45-degree field of view; 2048 x 1536 pixels; retinal fundus photograph:
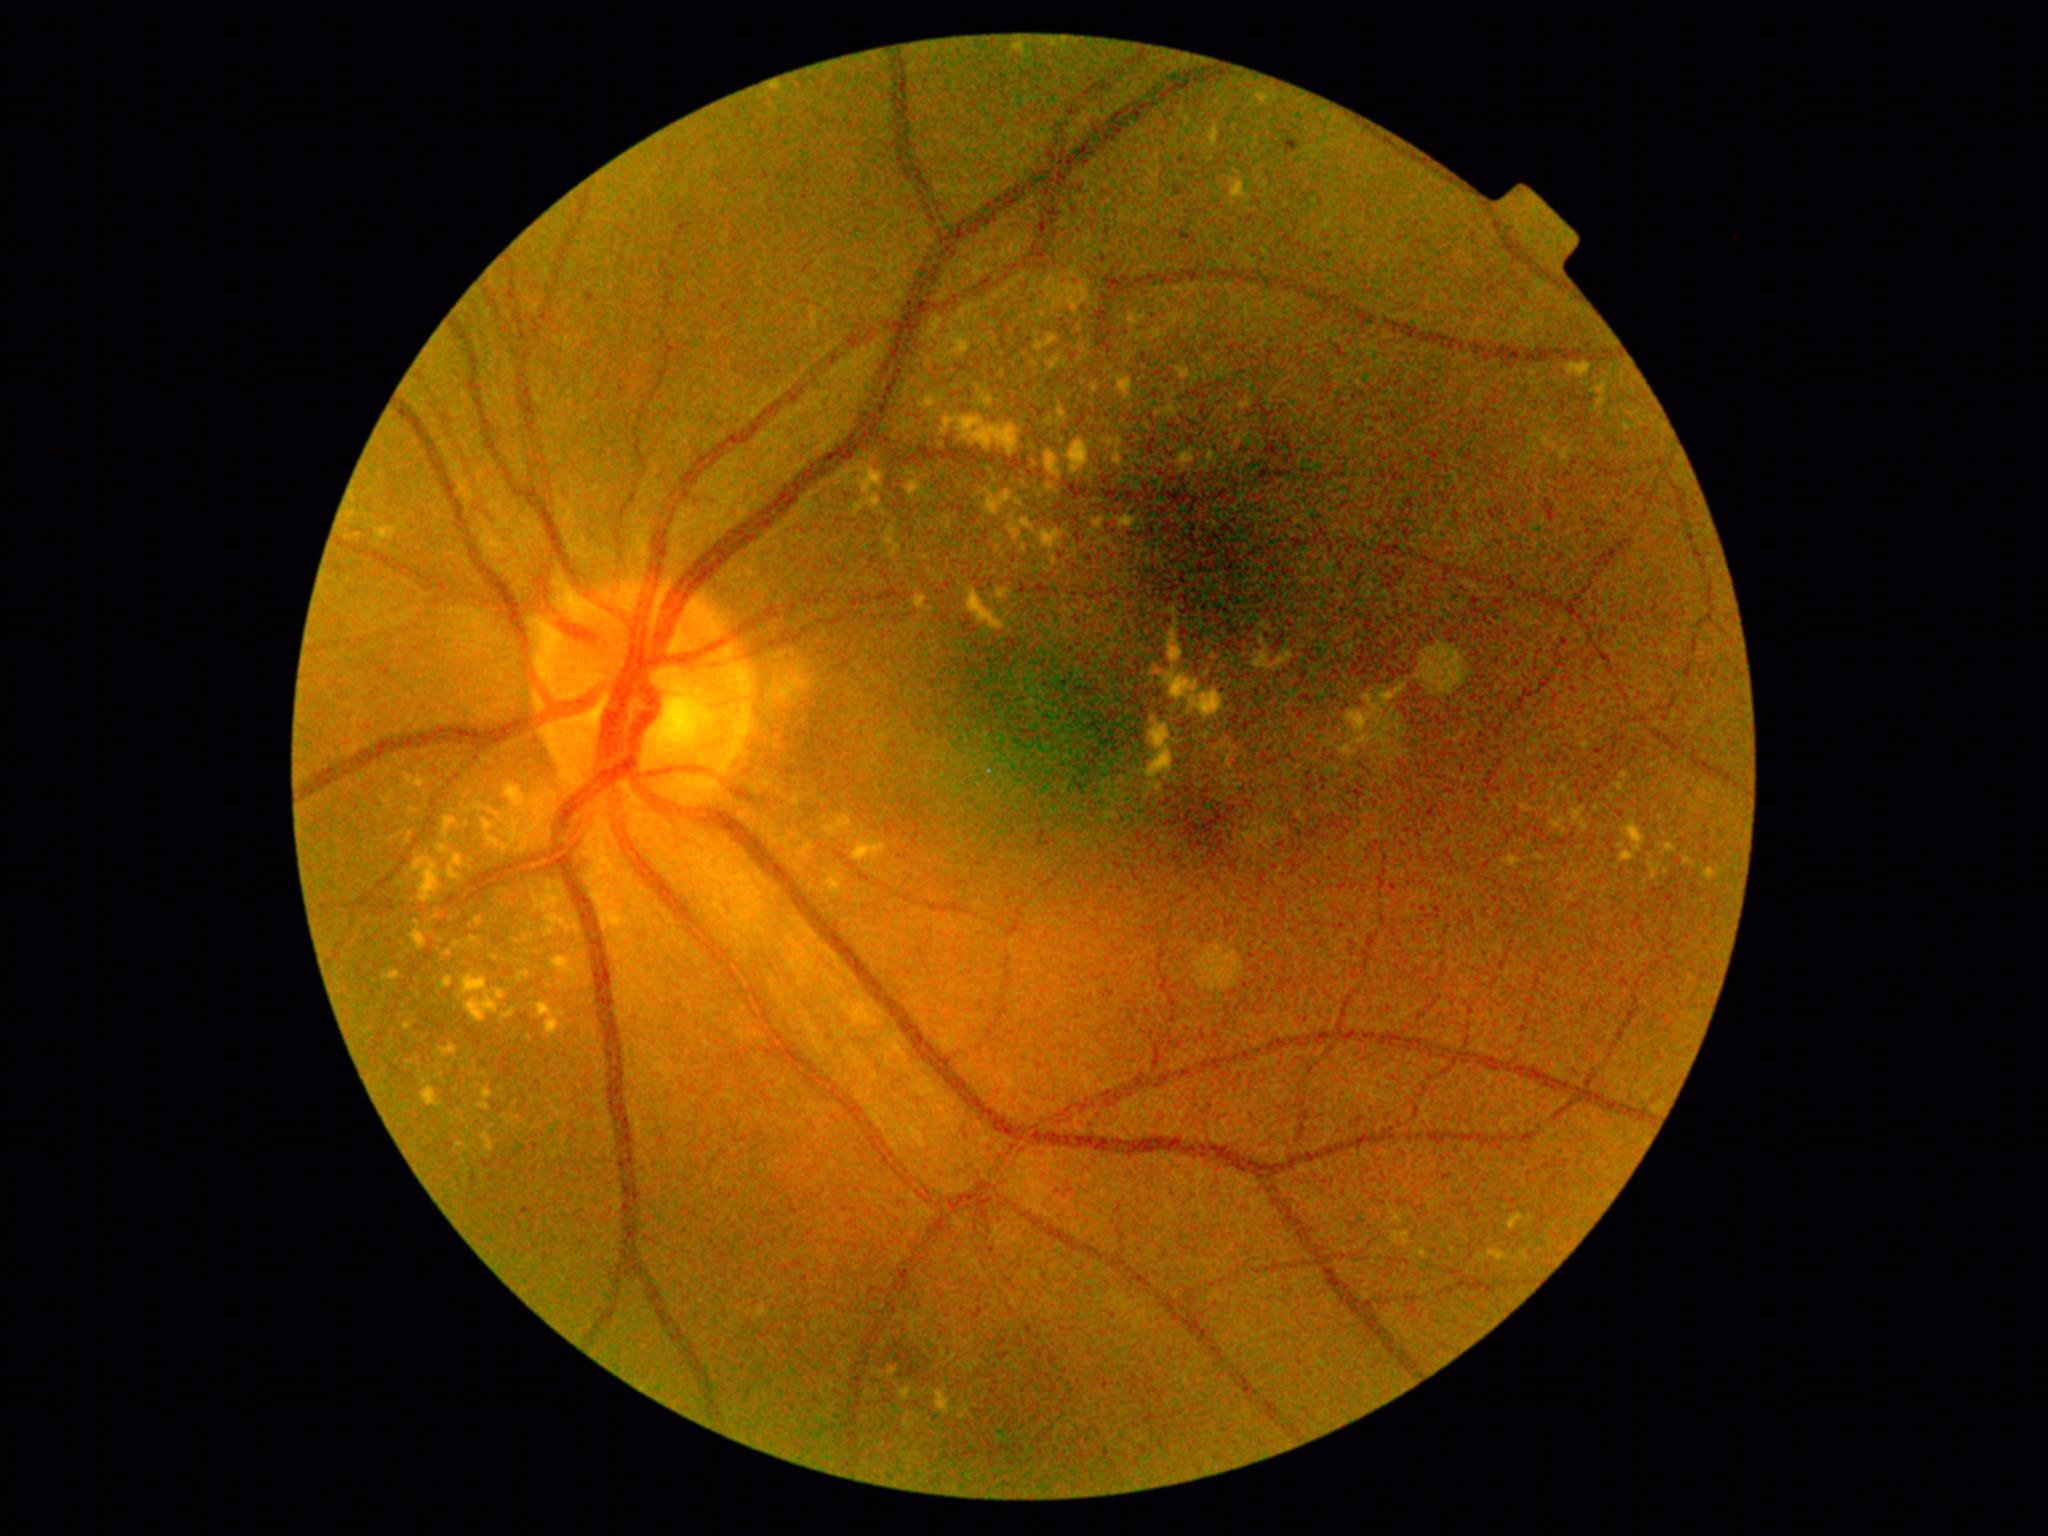 Diabetic retinopathy (DR) is grade 2 (moderate NPDR)
Selected lesions:
hard exudates (EXs) (partial): [left=536, top=894, right=559, bottom=911]; [left=1047, top=338, right=1055, bottom=347]; [left=1155, top=667, right=1199, bottom=701]; [left=1069, top=440, right=1086, bottom=473]; [left=1705, top=869, right=1714, bottom=880]; [left=1666, top=845, right=1675, bottom=852]; [left=446, top=818, right=456, bottom=829]; [left=1537, top=855, right=1545, bottom=861]; [left=1620, top=852, right=1633, bottom=862]; [left=546, top=1020, right=559, bottom=1034]; [left=413, top=931, right=426, bottom=948]; [left=388, top=973, right=400, bottom=980]
EXs (small, approximate centers) near x=1627 y=427; x=1211 y=458; x=1481 y=1257; x=1621 y=847; x=866 y=487; x=1688 y=861